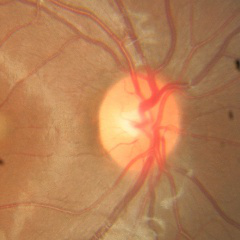

Findings consistent with no glaucomatous findings.